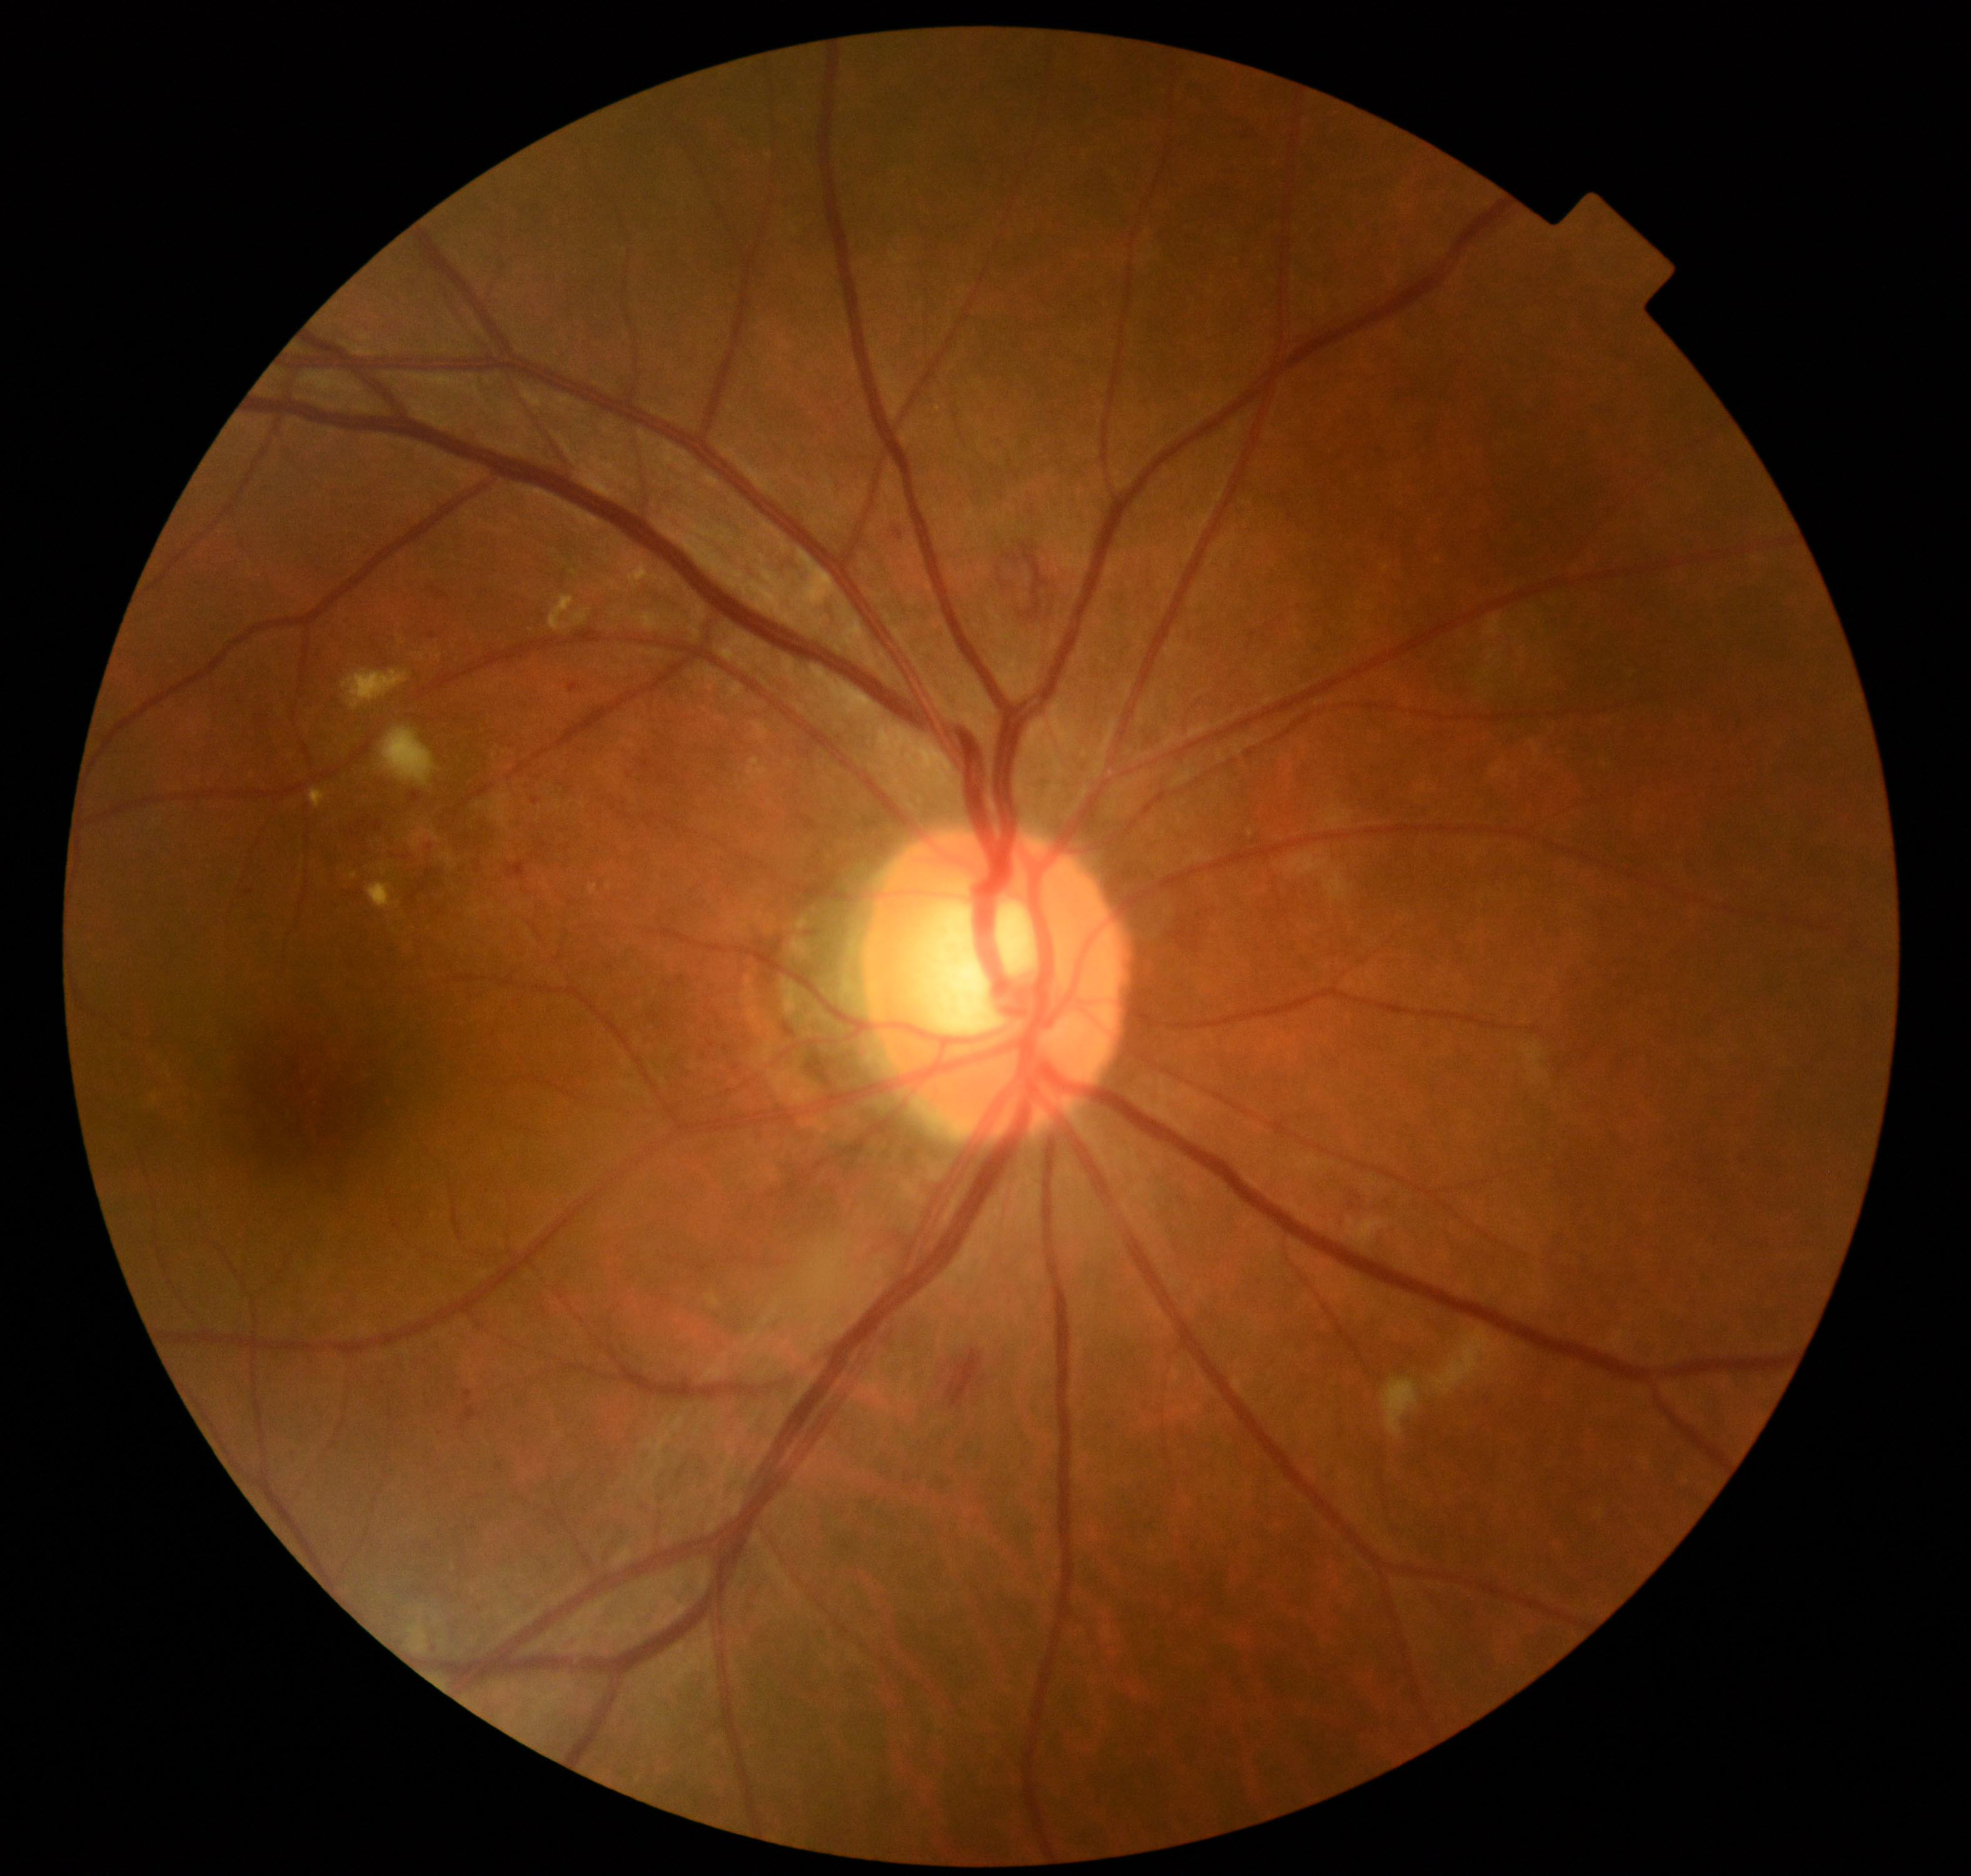 Appearance consistent with moderate non-proliferative diabetic retinopathy.